848 x 848 pixels; NIDEK AFC-230 fundus camera:
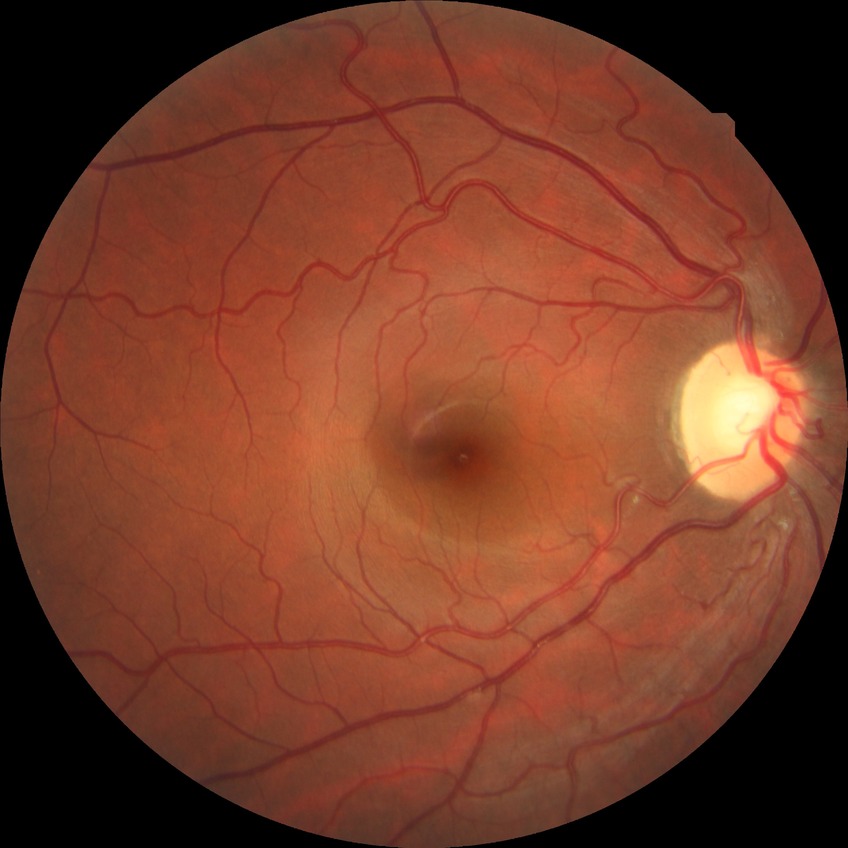 Modified Davis classification is no diabetic retinopathy.